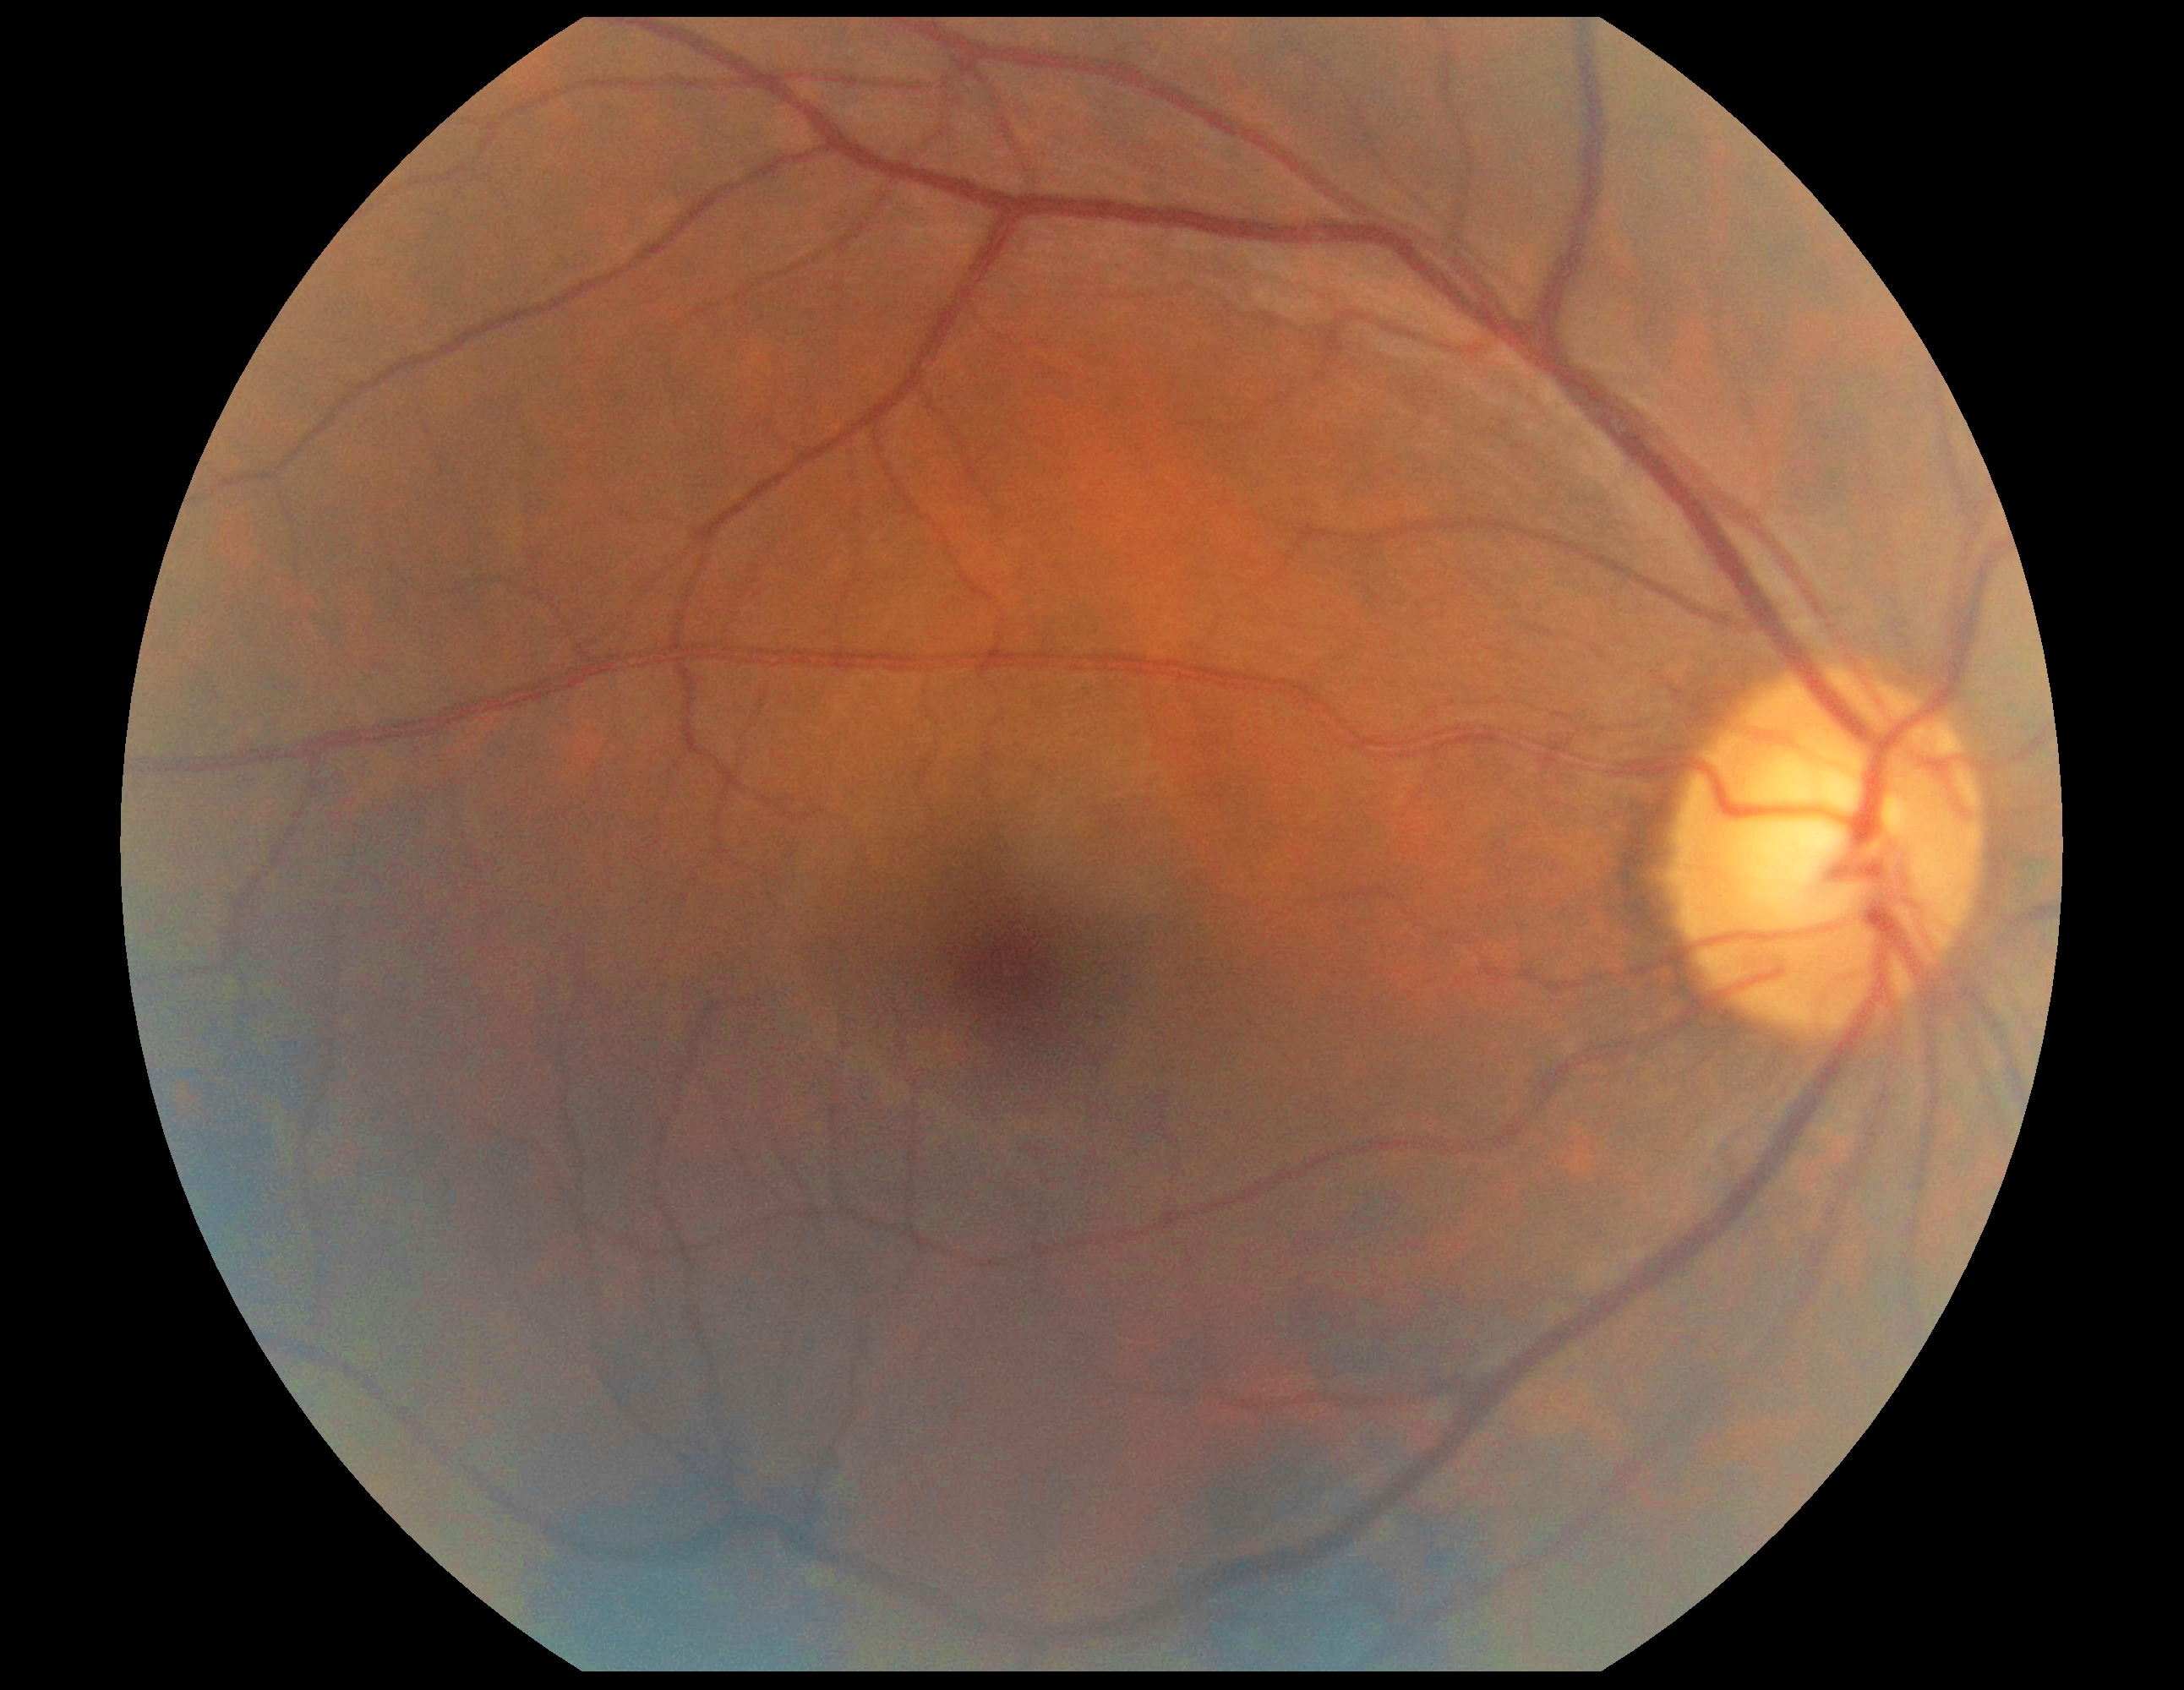
Diabetic retinopathy (DR) is 0.